45° field of view; 2352 by 1568 pixels: 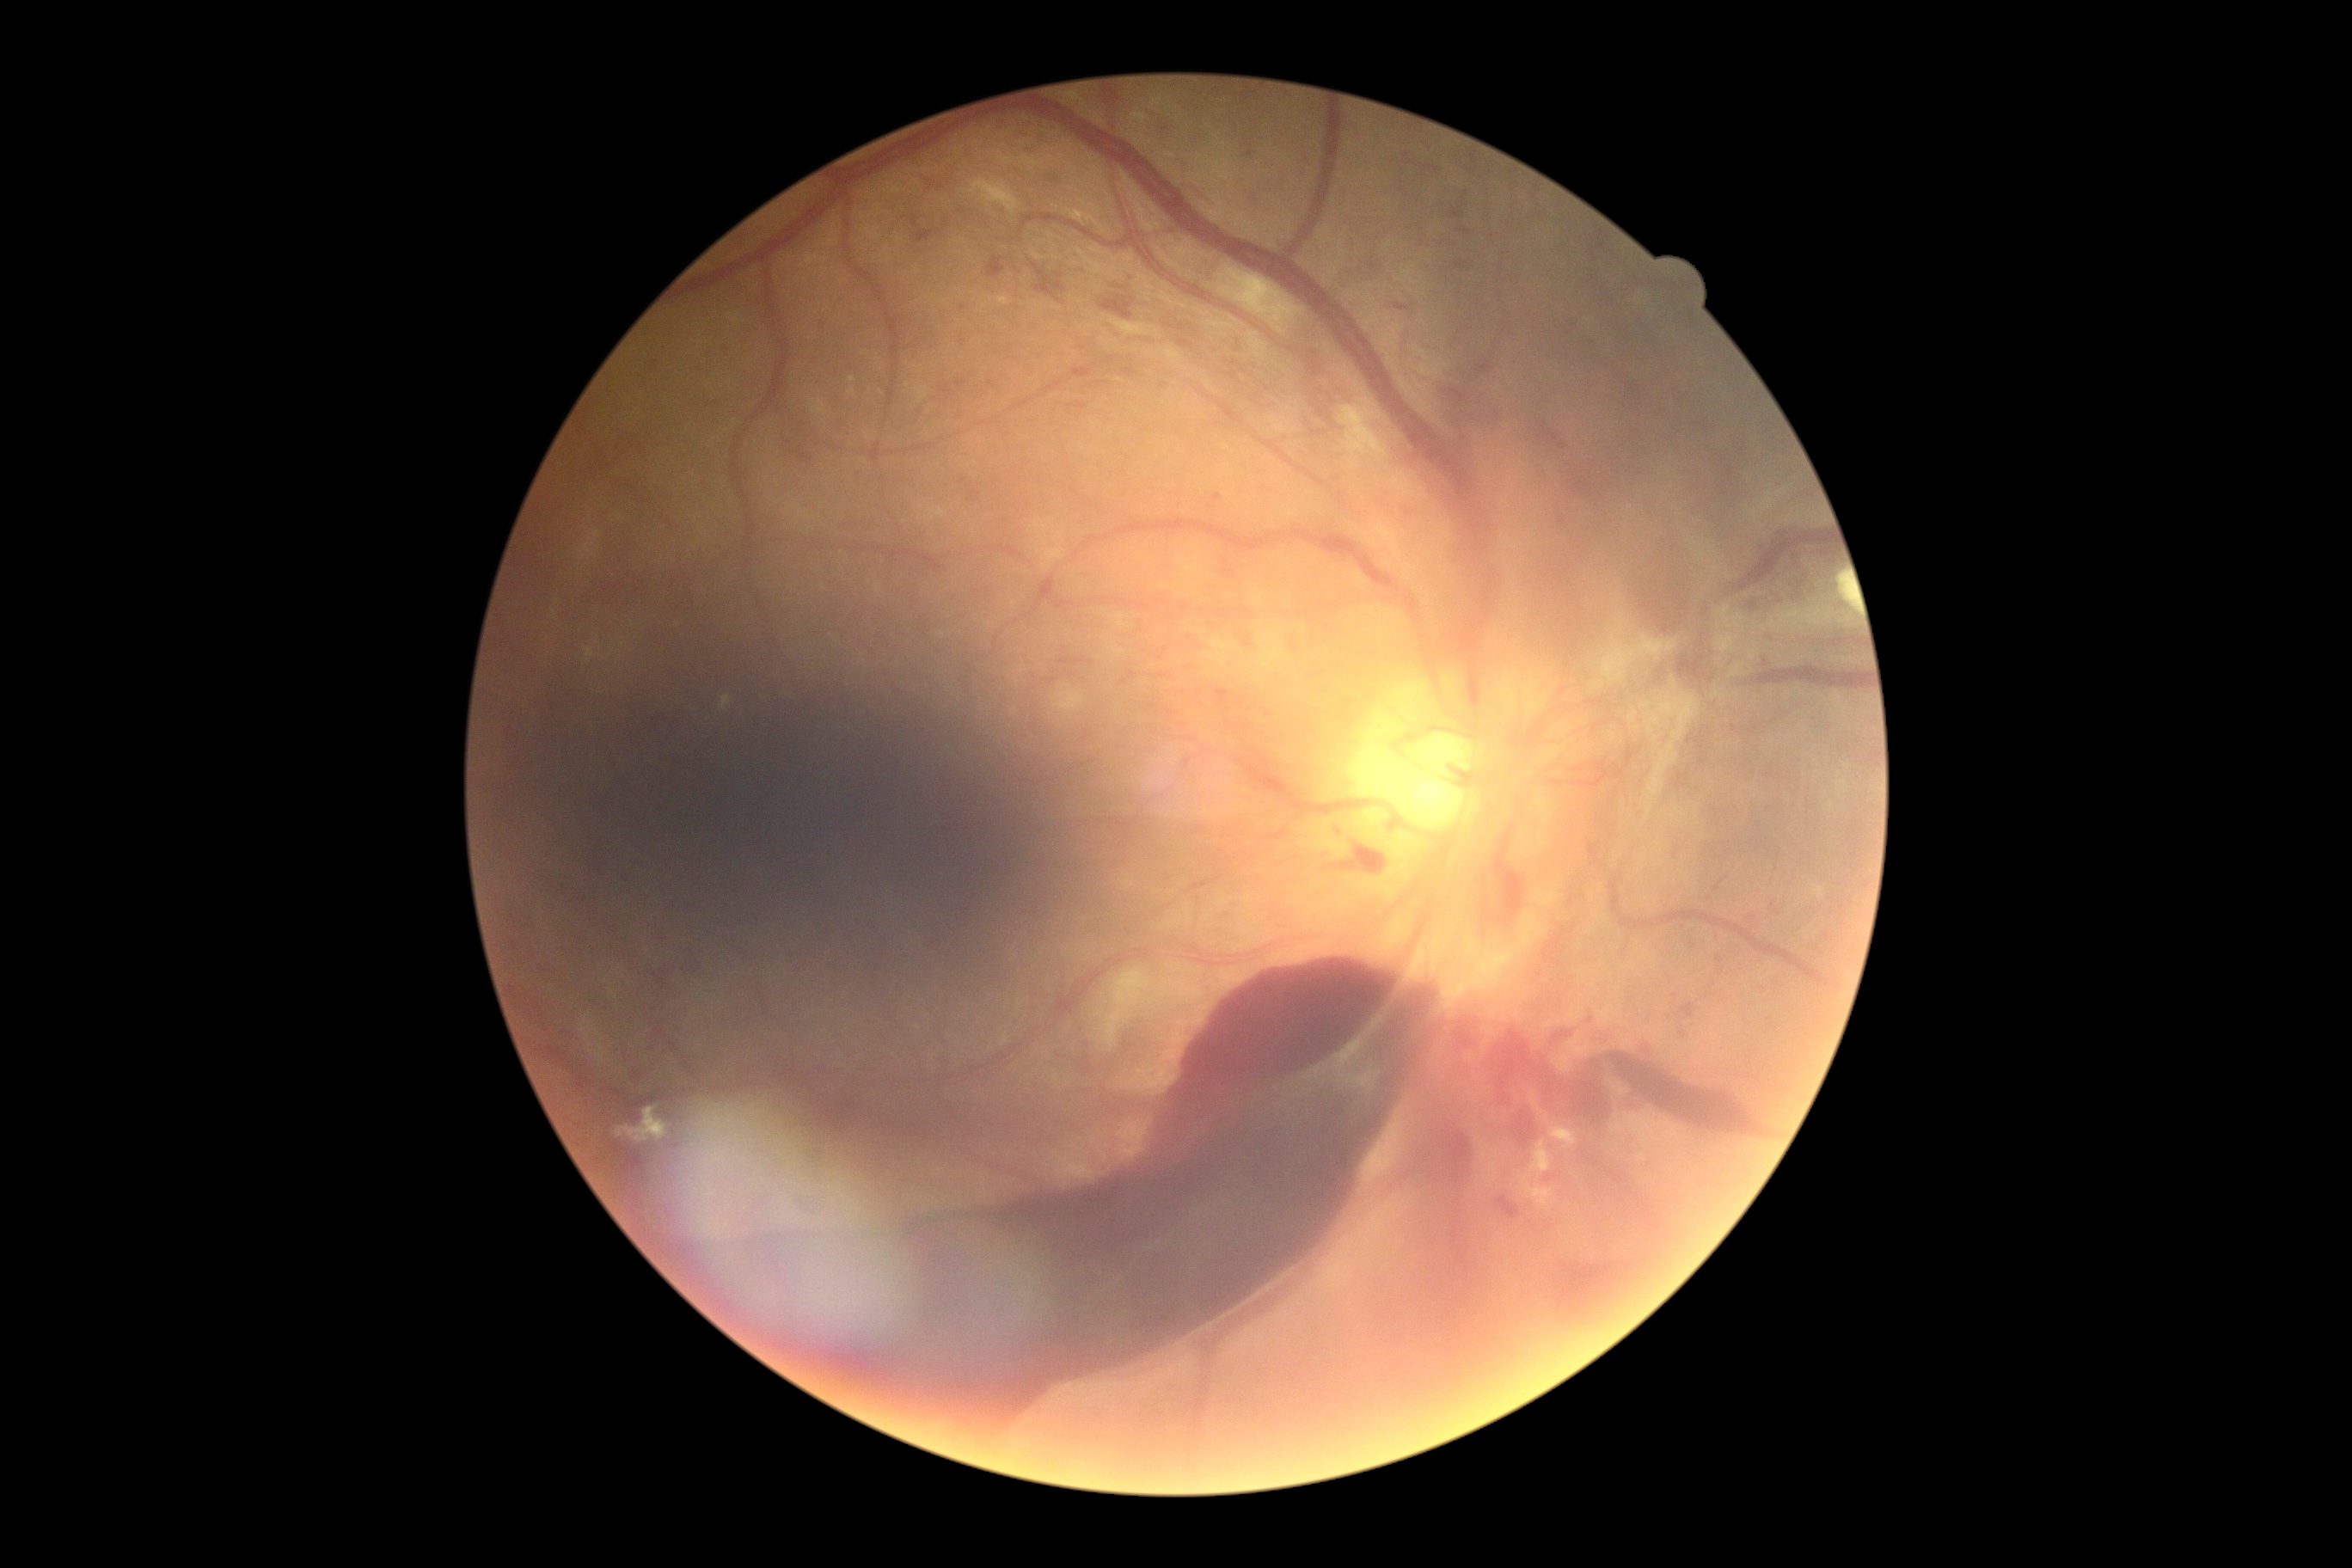
{"dr_grade": "PDR (grade 4) — neovascularization and/or vitreous/pre-retinal hemorrhage"}